45-degree field of view:
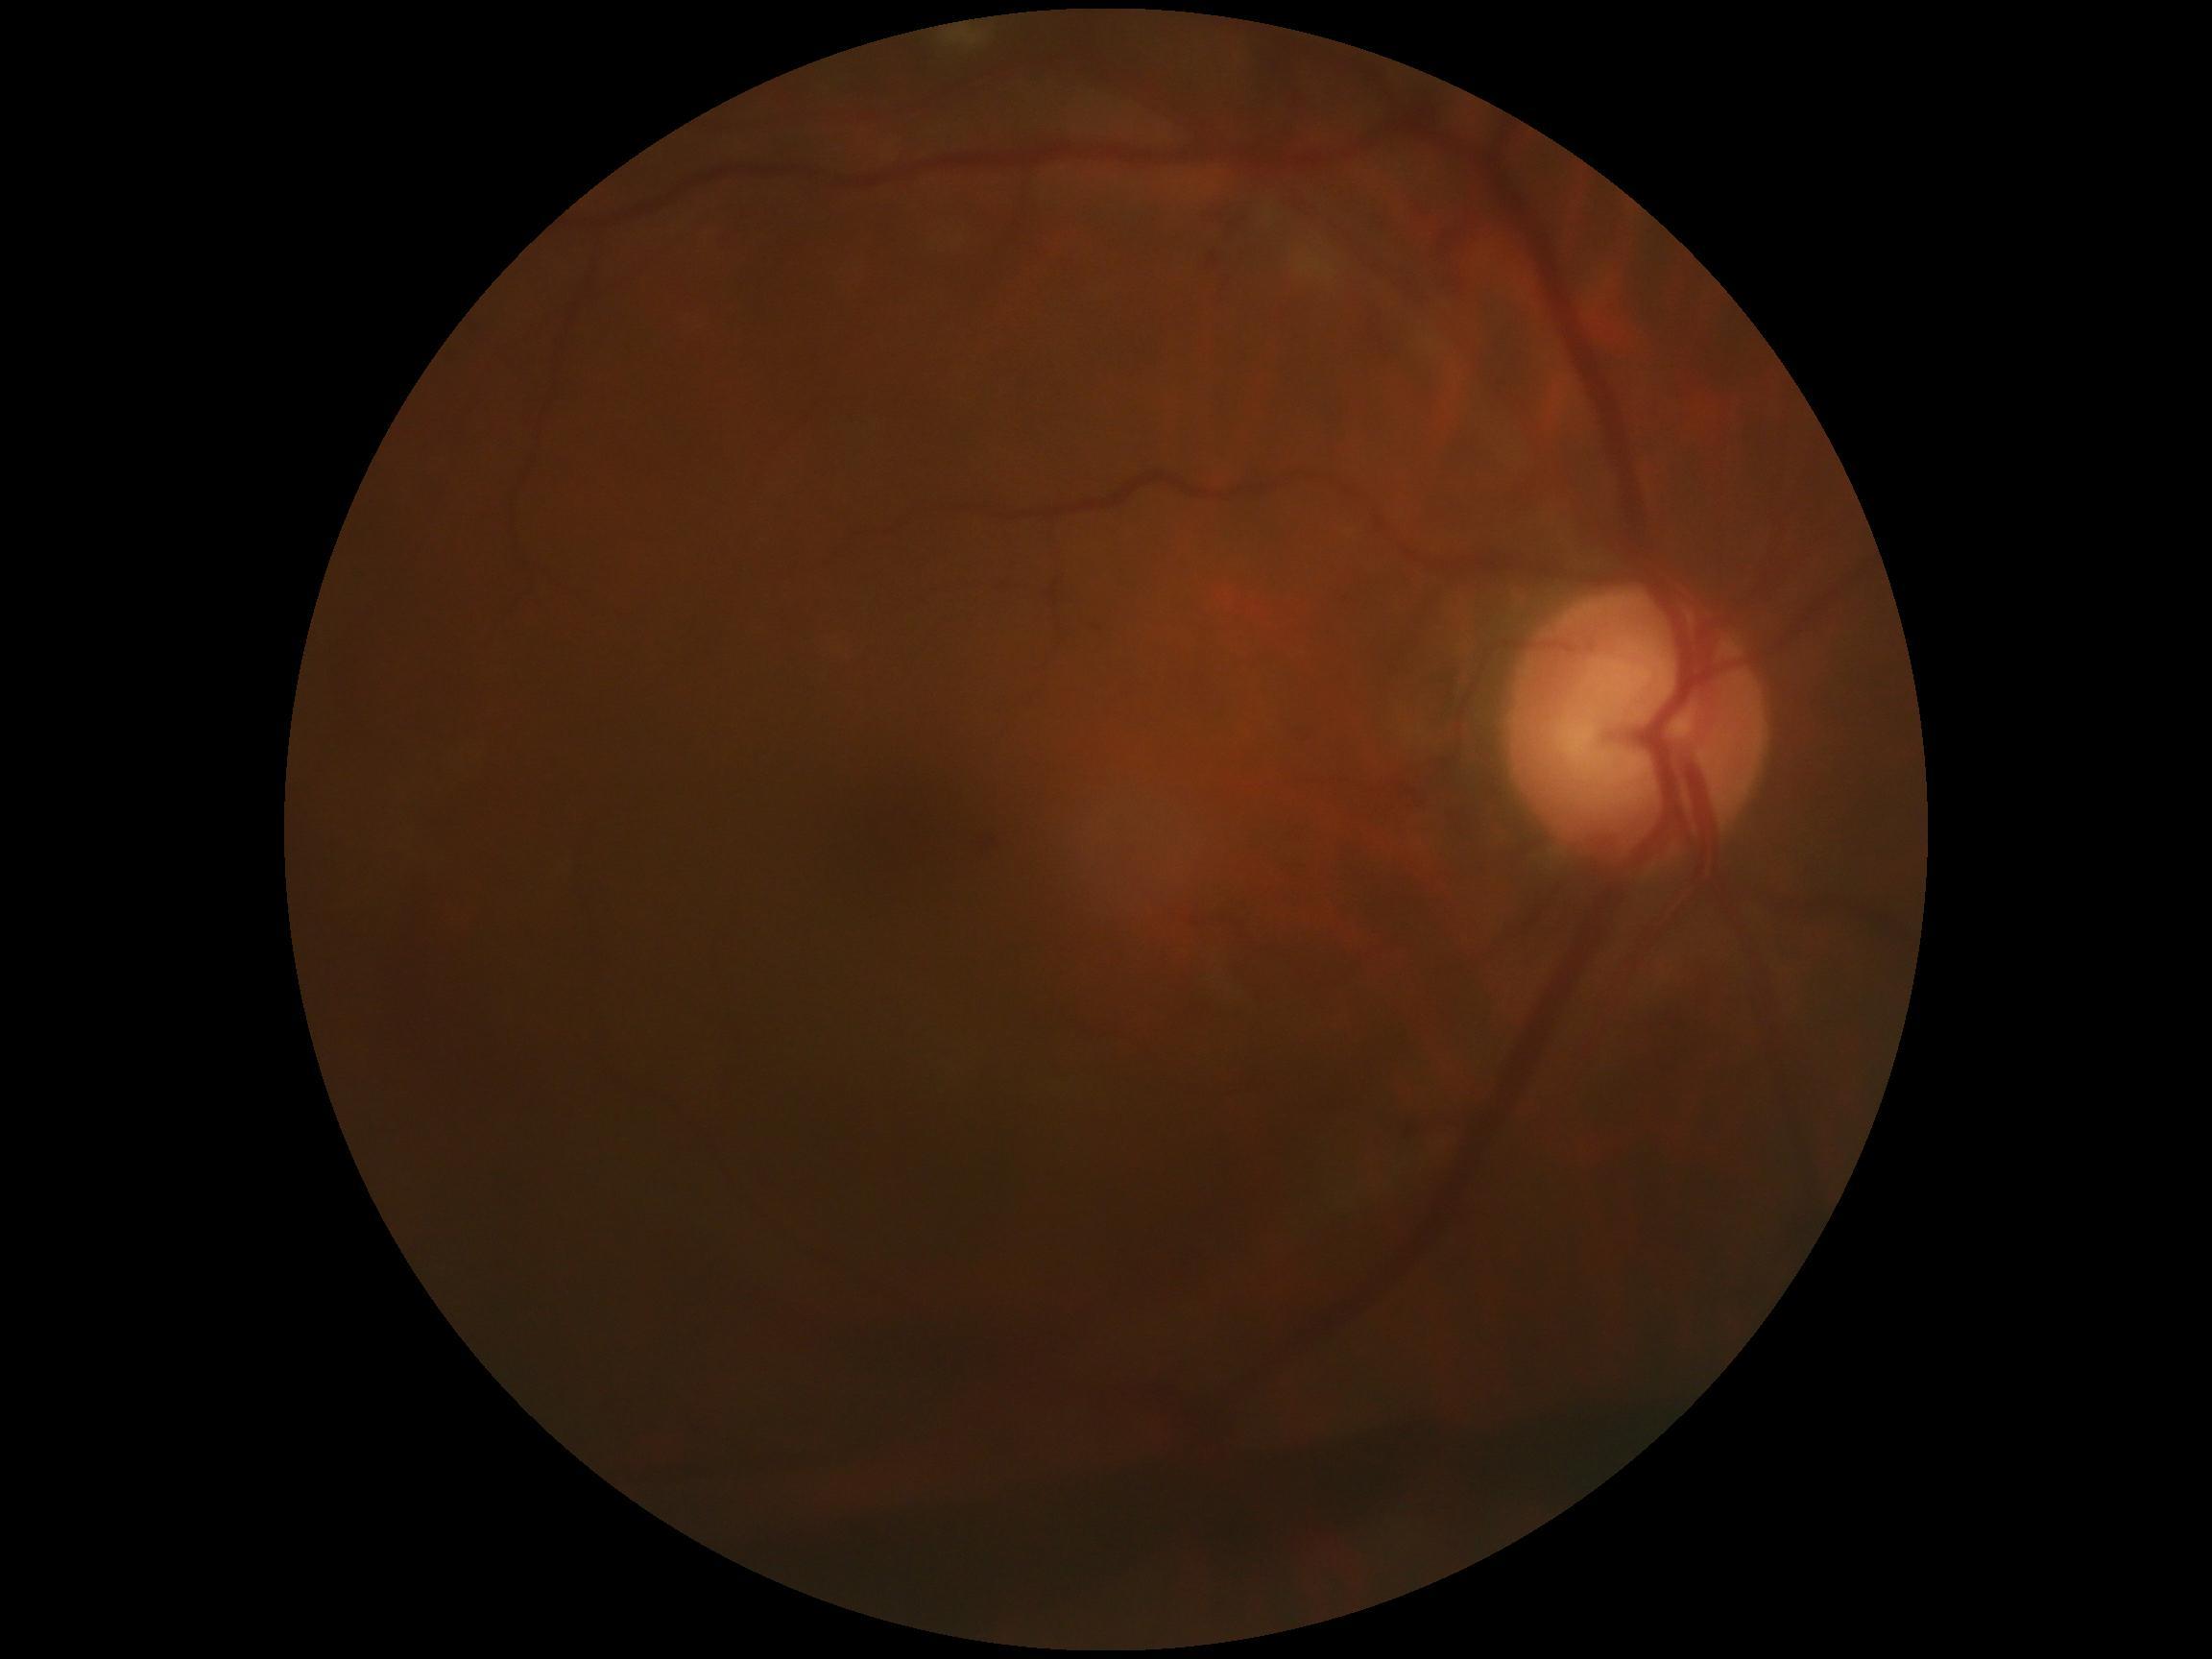 • retinopathy grade: 4 (PDR)
• DR class: proliferative diabetic retinopathy